RetCam wide-field infant fundus image. Image size 640x480
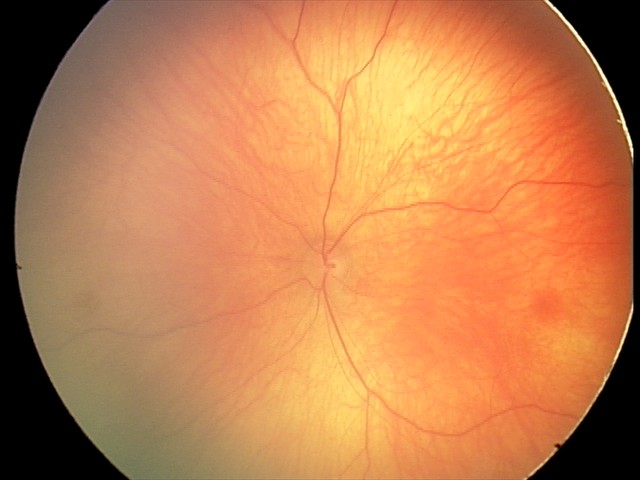
Screening examination with no abnormal retinal findings.